FOV: 45 degrees; CFP.
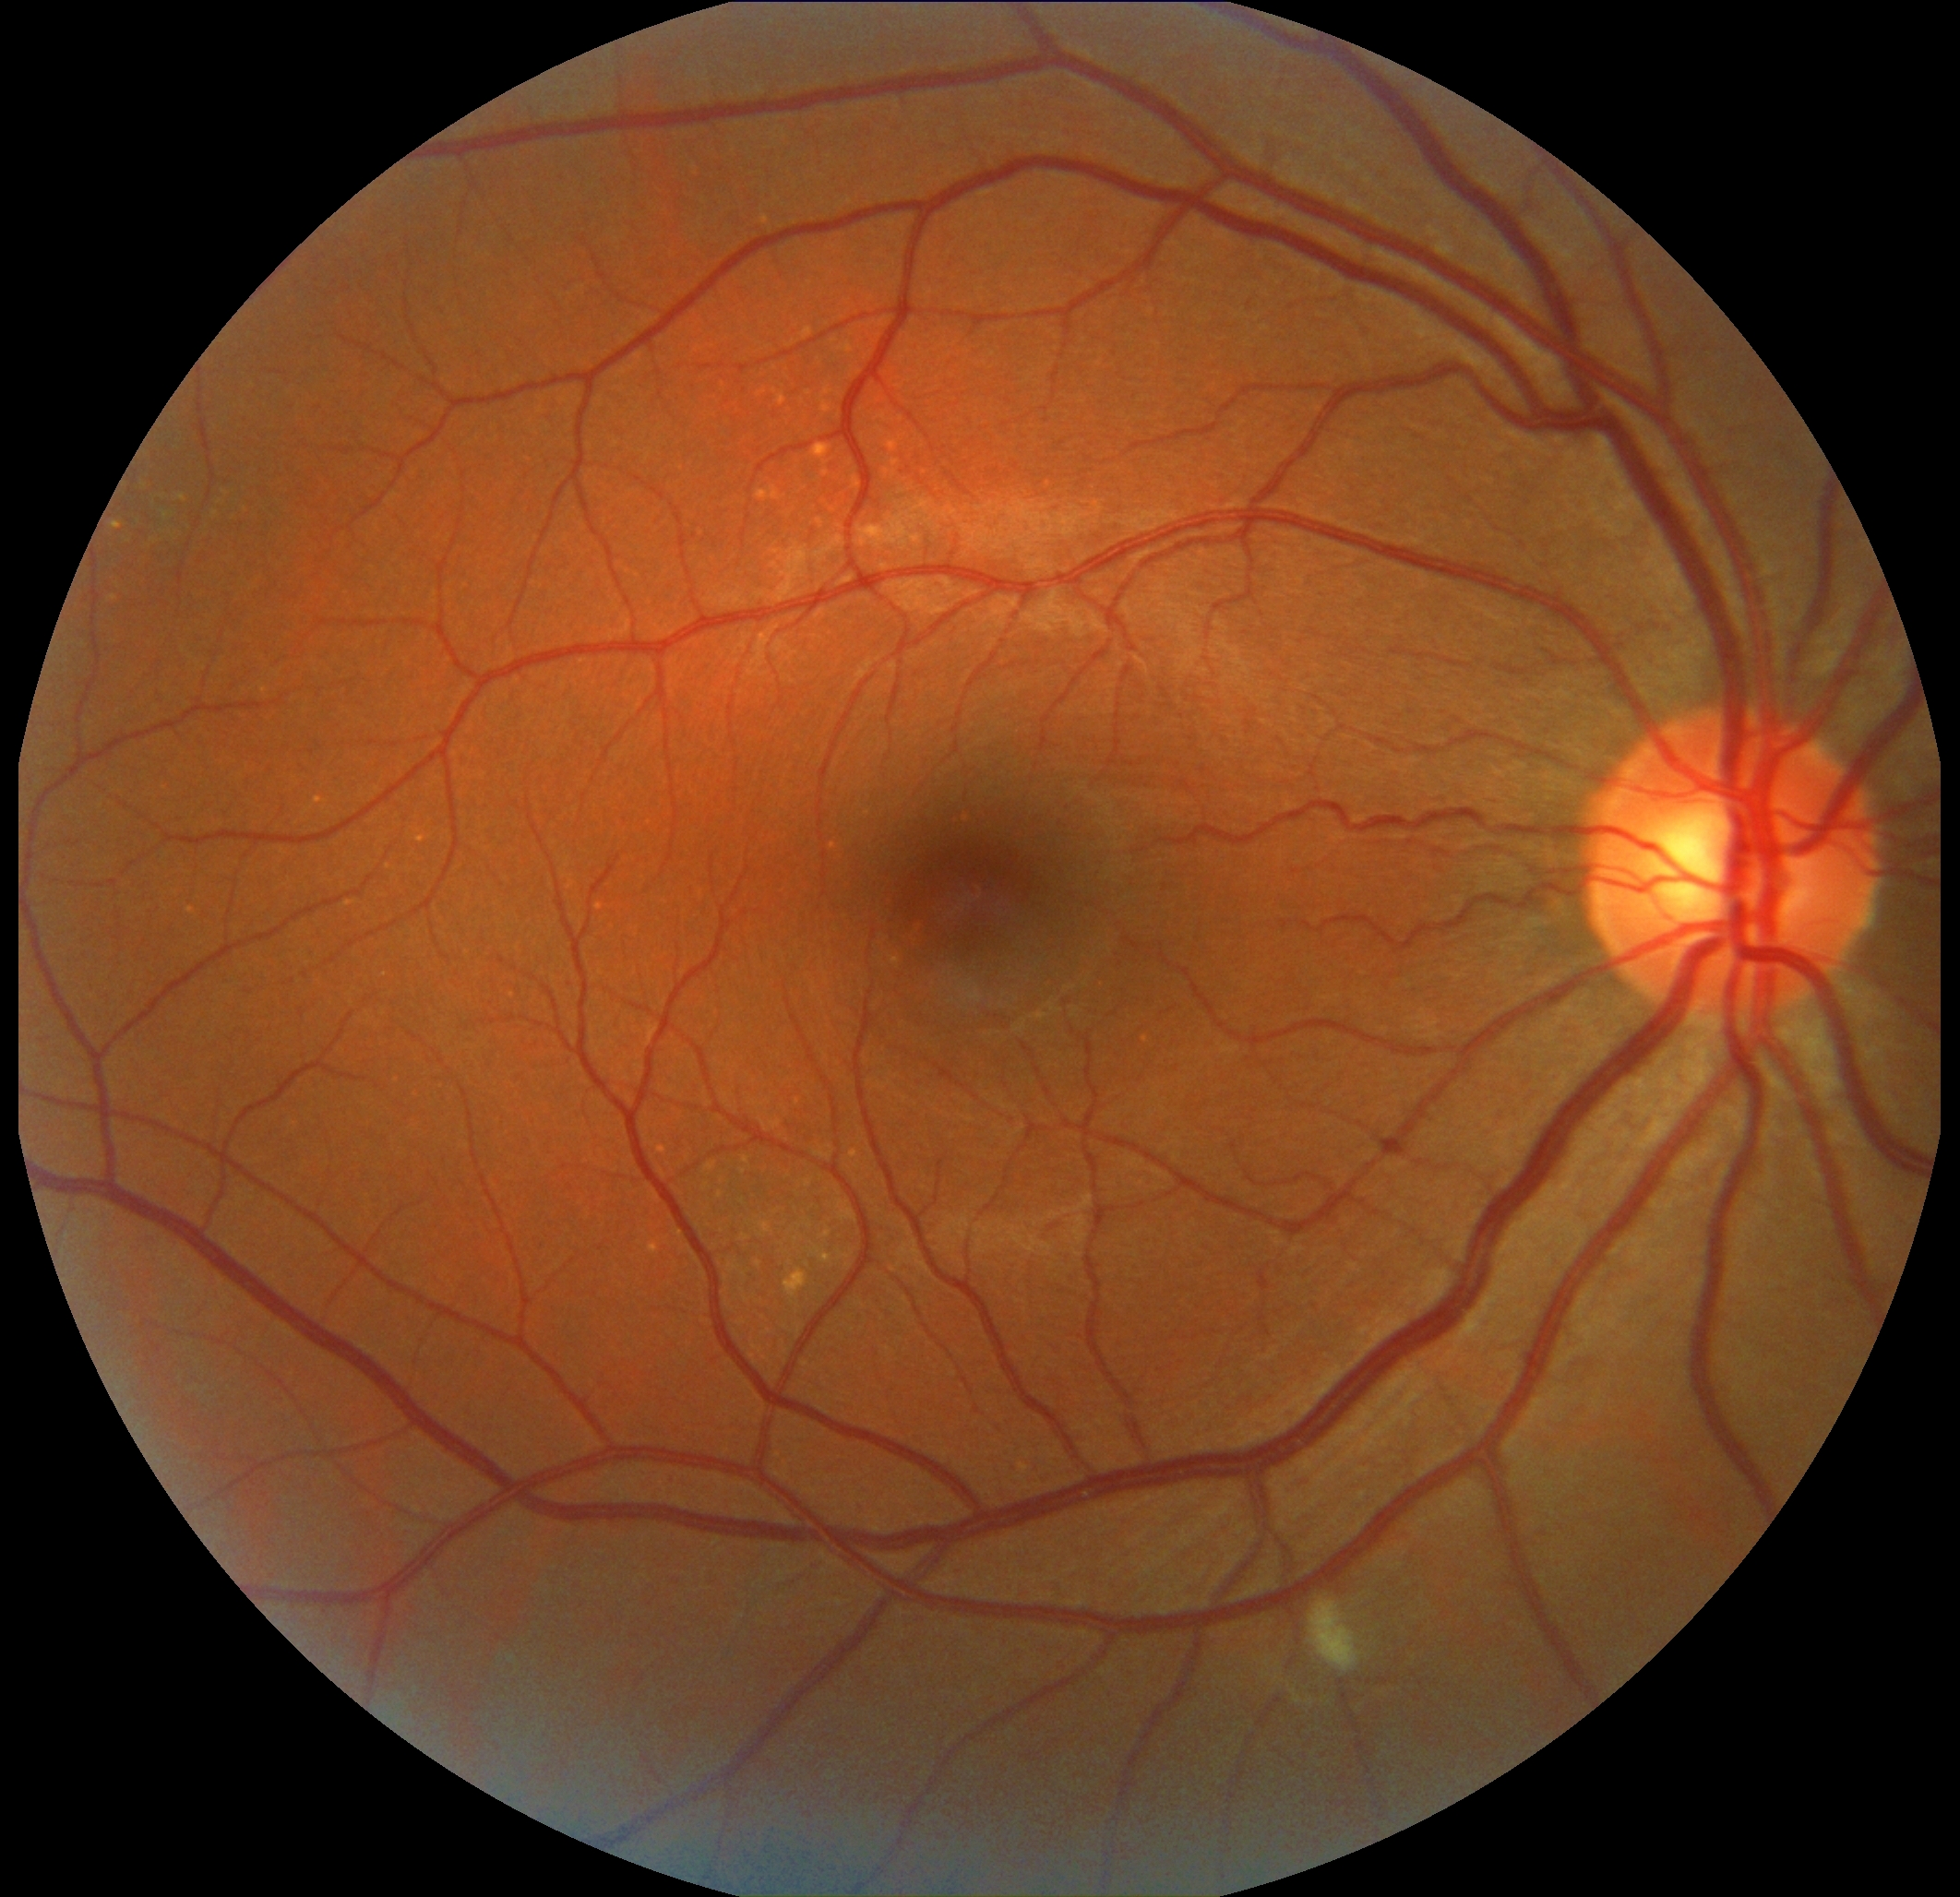
DR class: non-proliferative diabetic retinopathy.
Diabetic retinopathy (DR): moderate non-proliferative diabetic retinopathy (grade 2).